Retinal fundus photograph
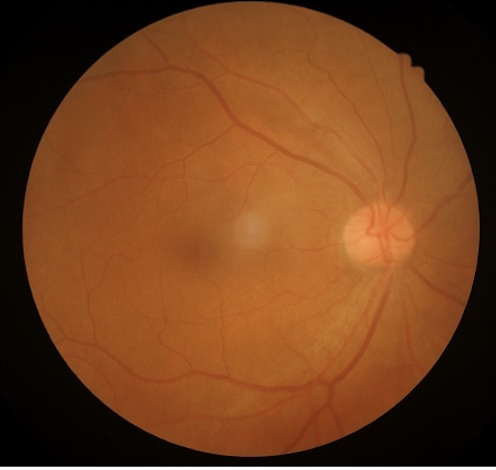
Image is sharp throughout the field. Overall image quality is good. Illumination is even.